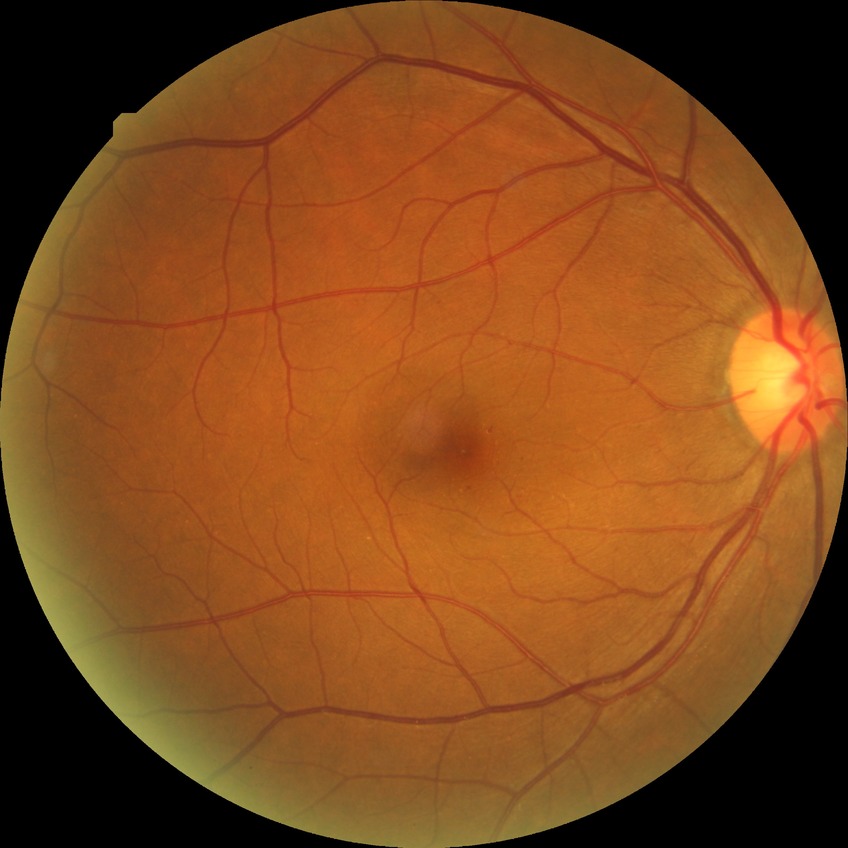 Modified Davis classification is simple diabetic retinopathy.